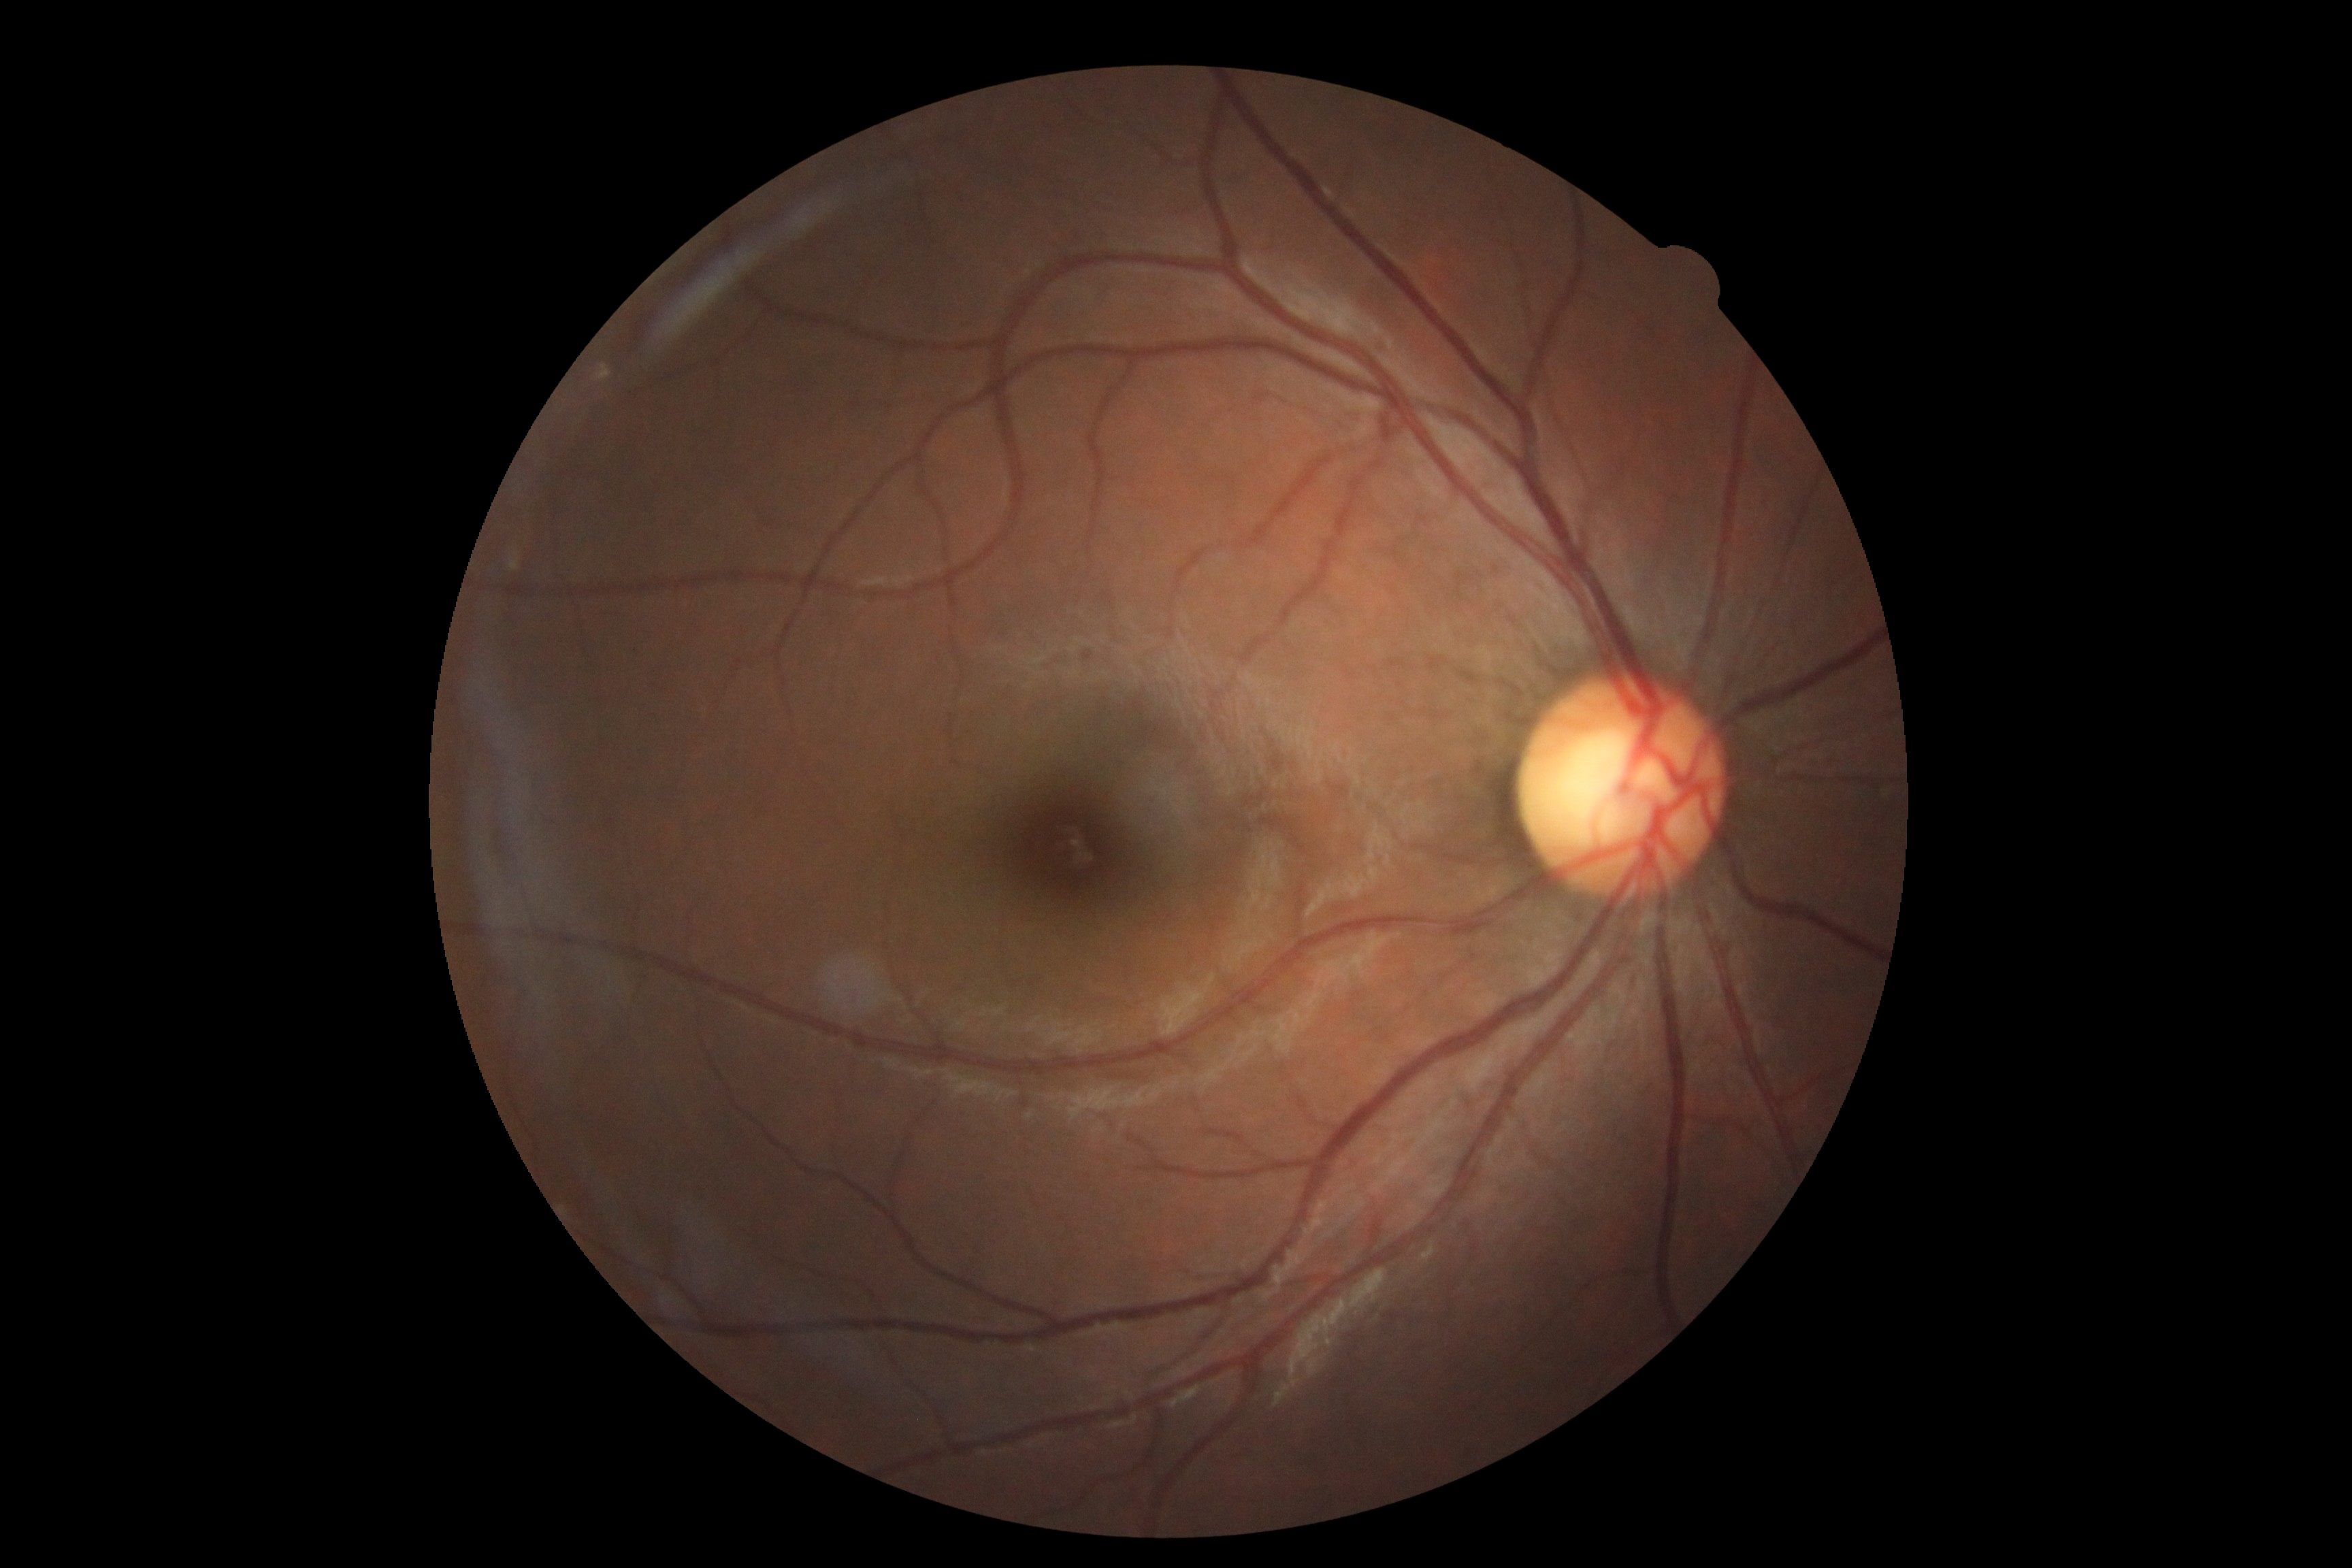 diabetic retinopathy (DR) = grade 0 (no apparent retinopathy).